CFP: 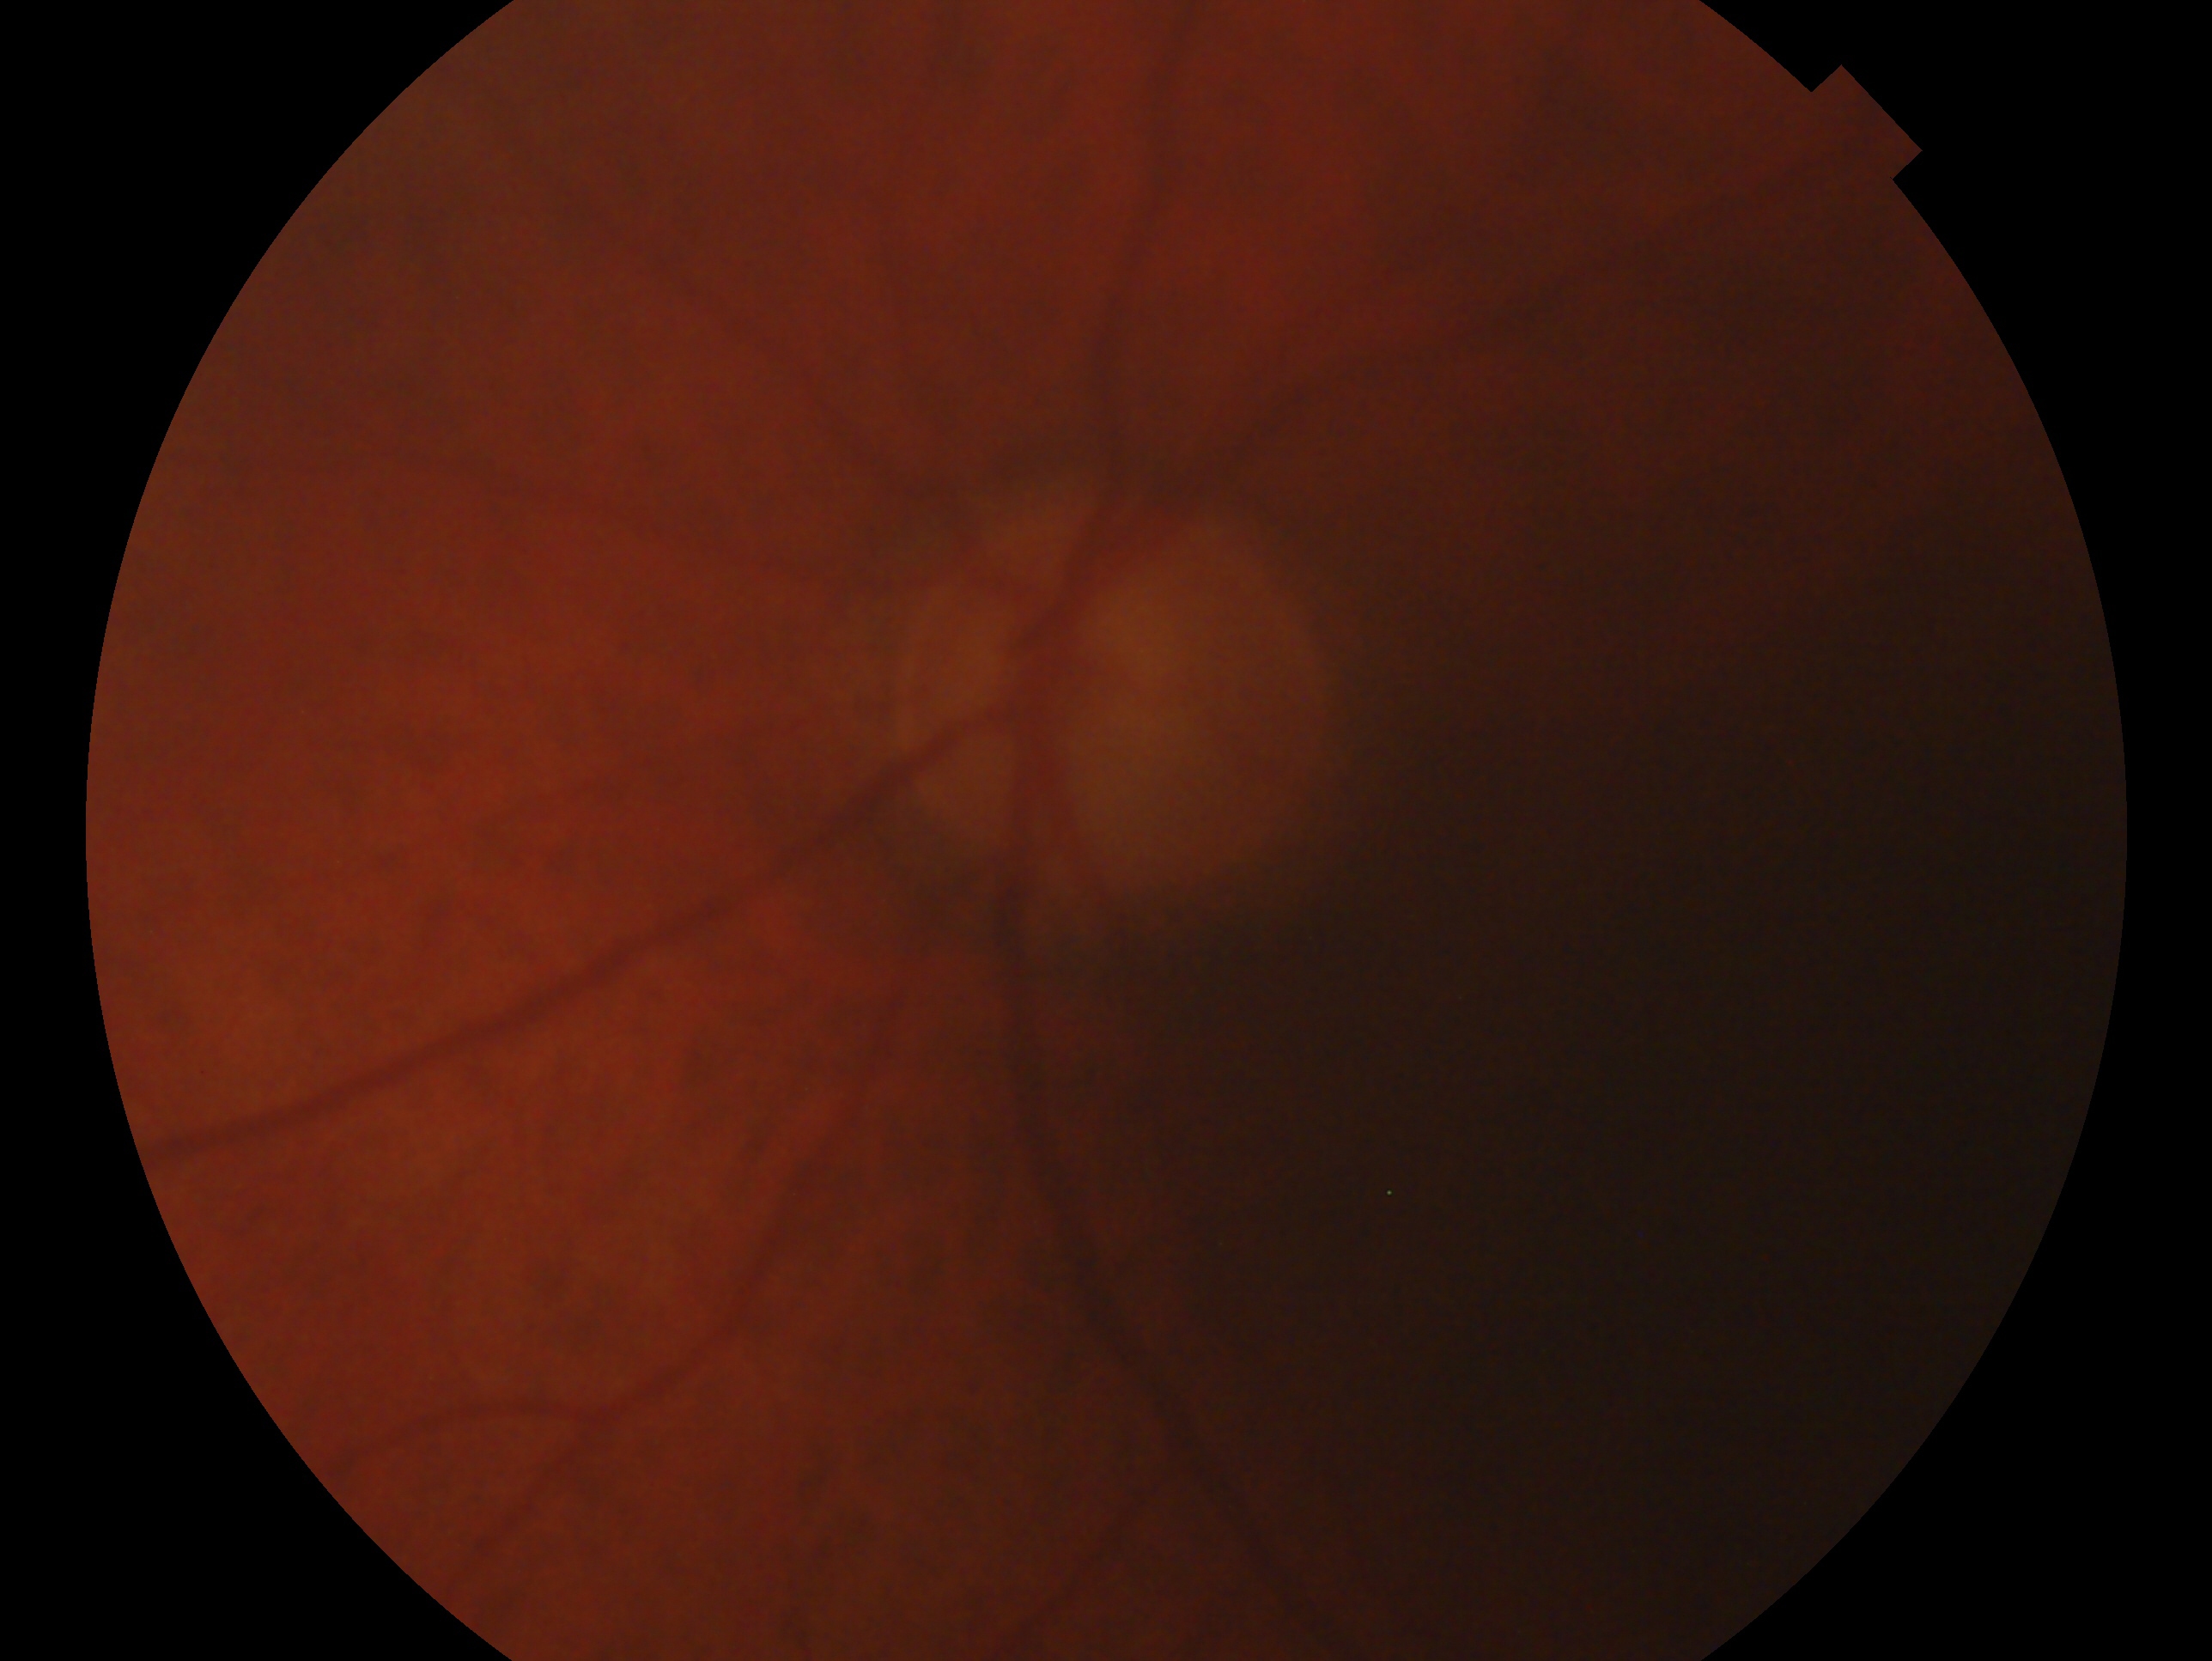 This is the left eye. Glaucoma assessment: consistent with glaucoma.